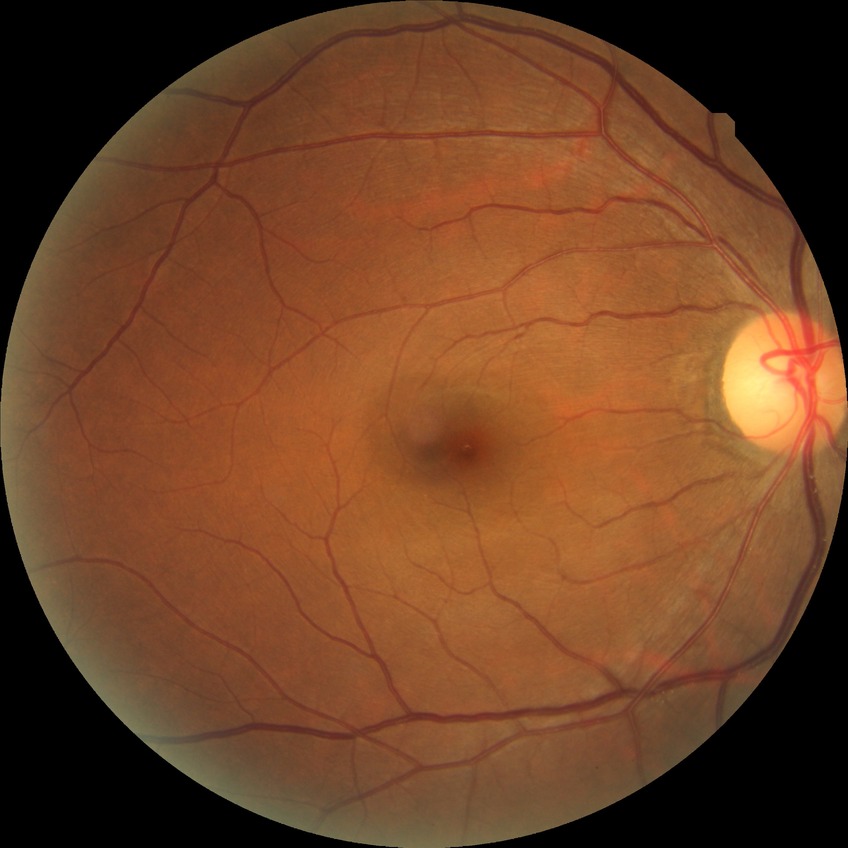

{"davis_grade": "no diabetic retinopathy"}